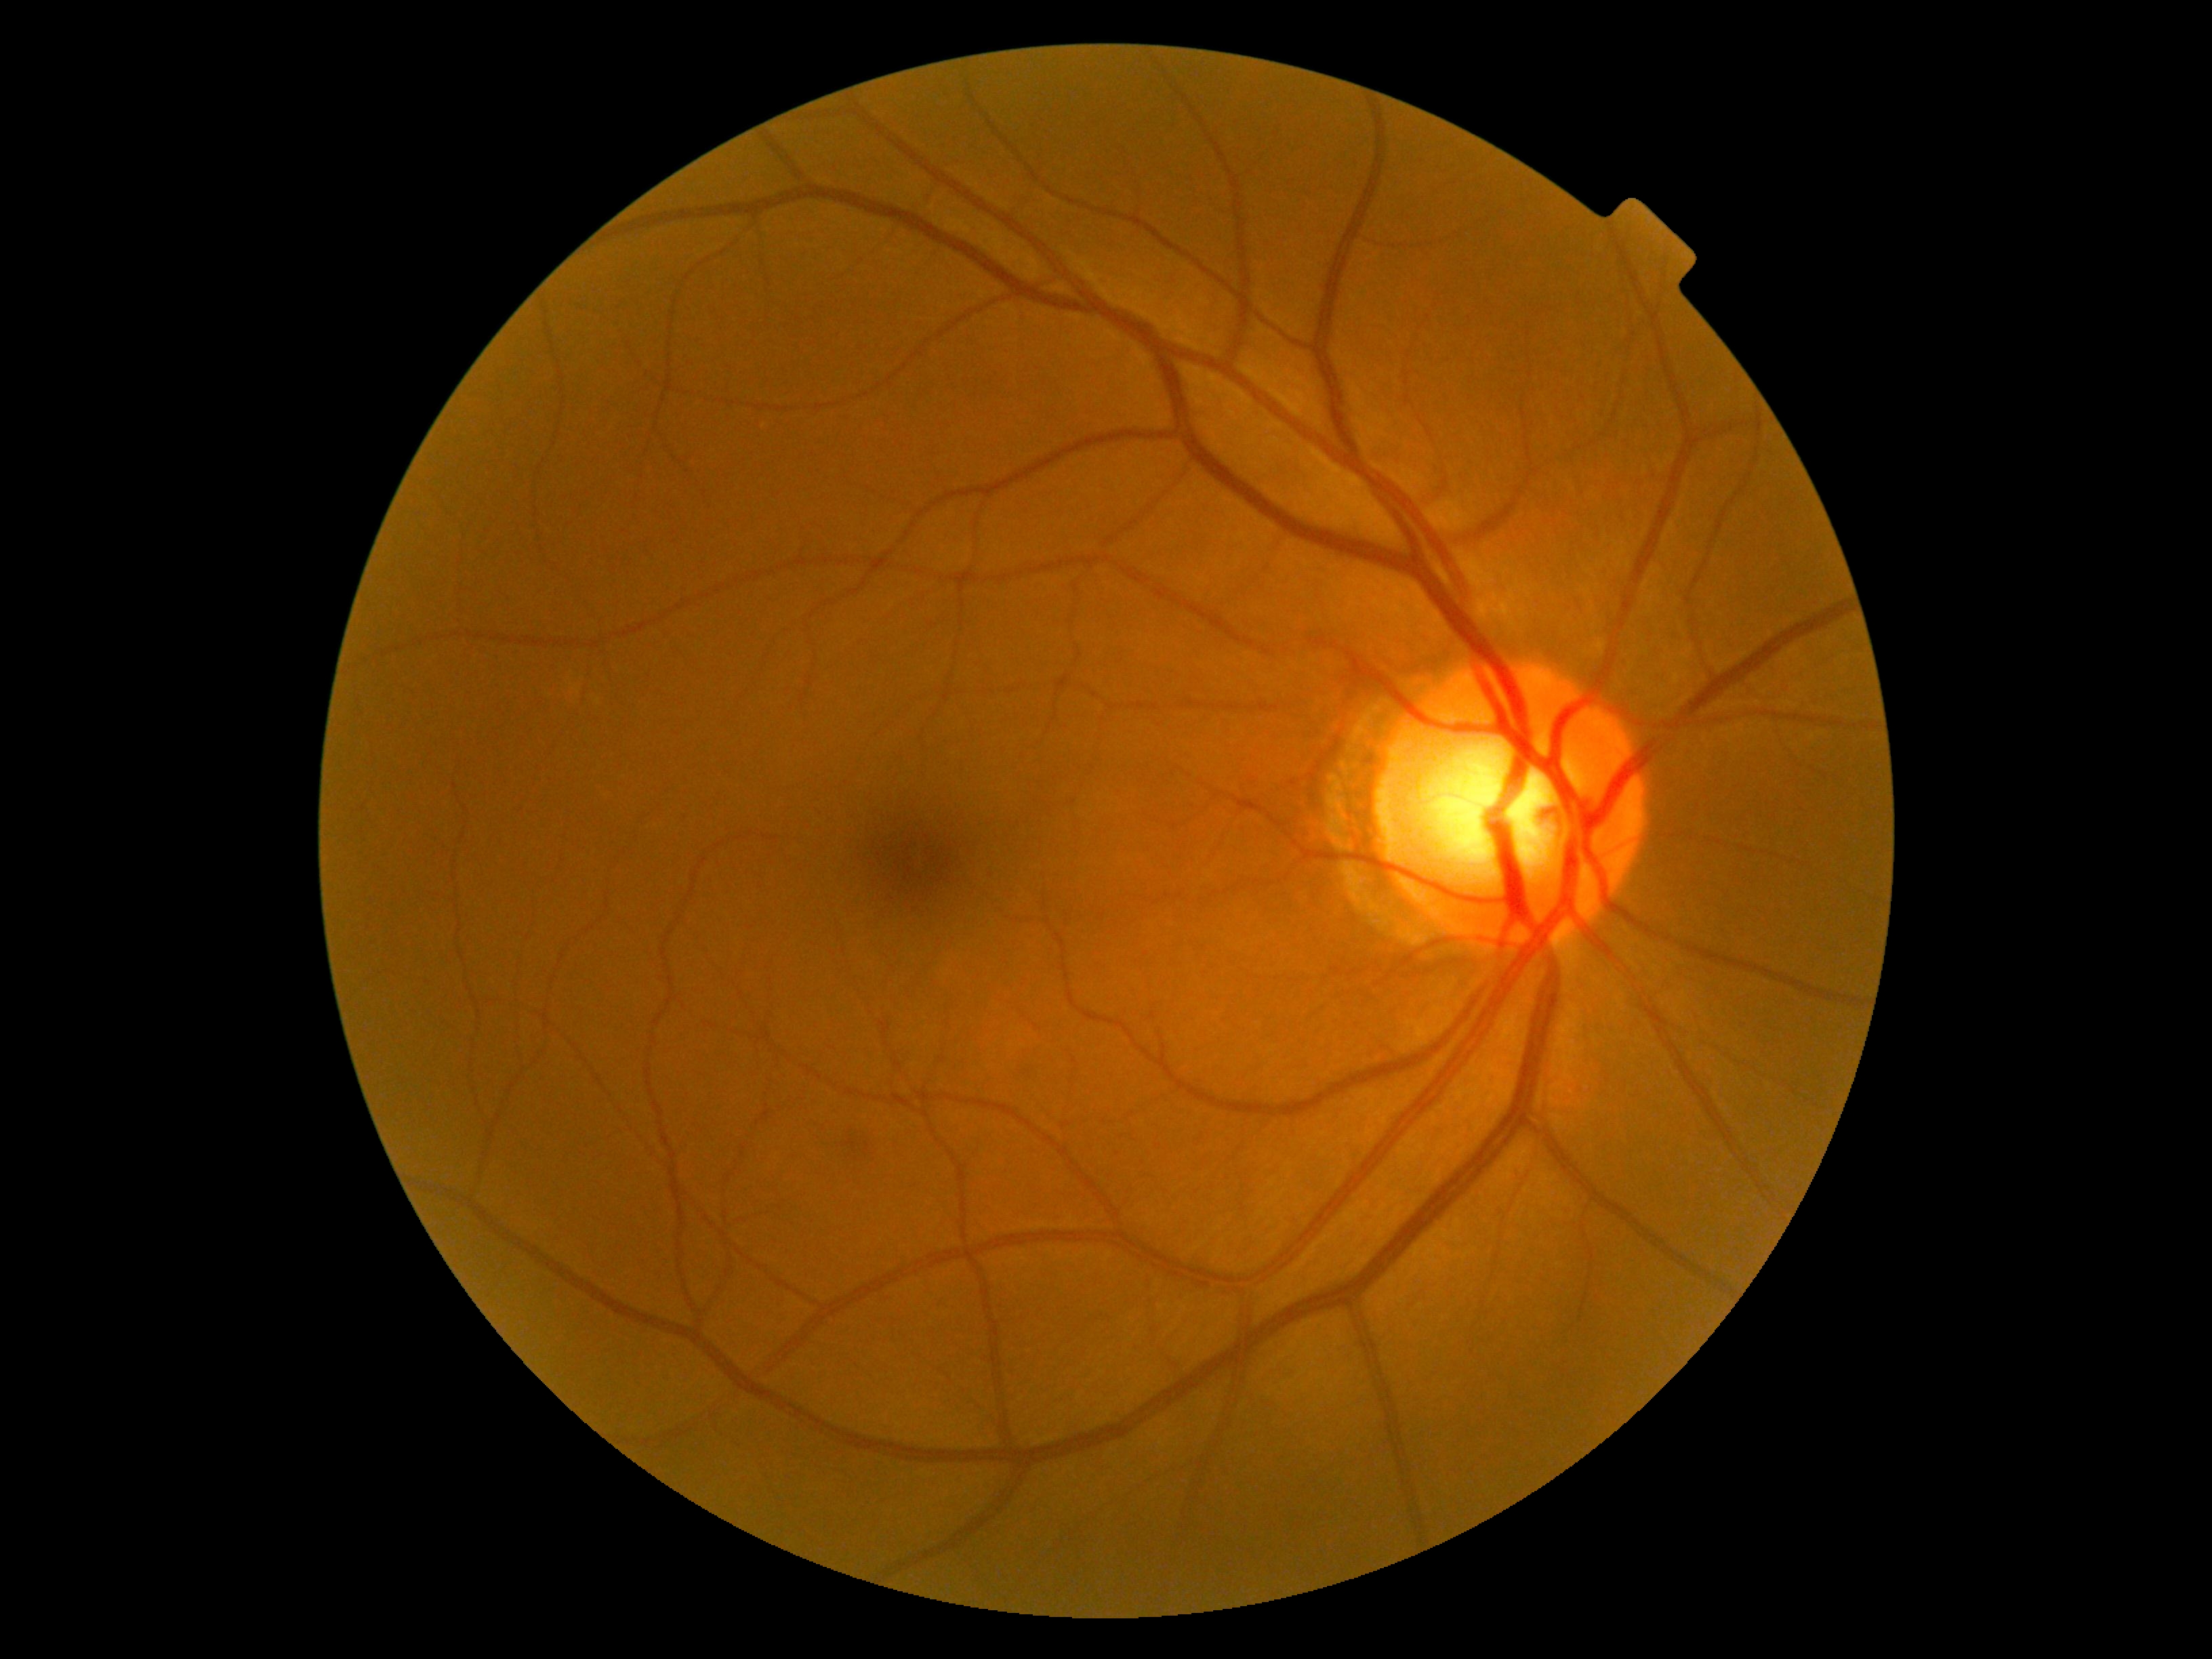
• DR class: non-proliferative diabetic retinopathy
• DR stage: moderate NPDR (grade 2)